130° field of view (Clarity RetCam 3). Infant wide-field fundus photograph: 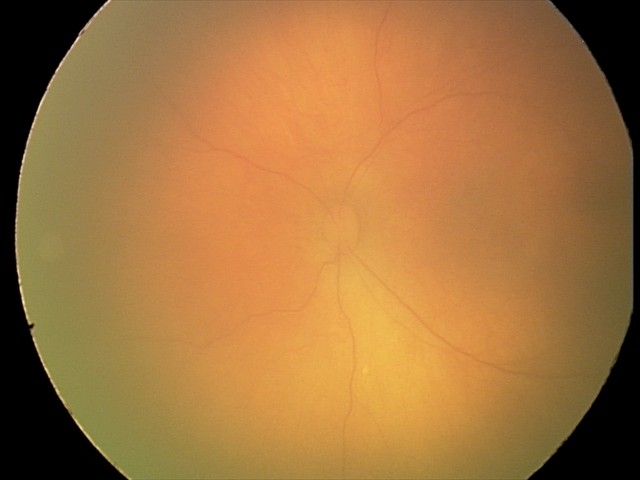 Screening diagnosis: physiological.